Portable fundus camera image:
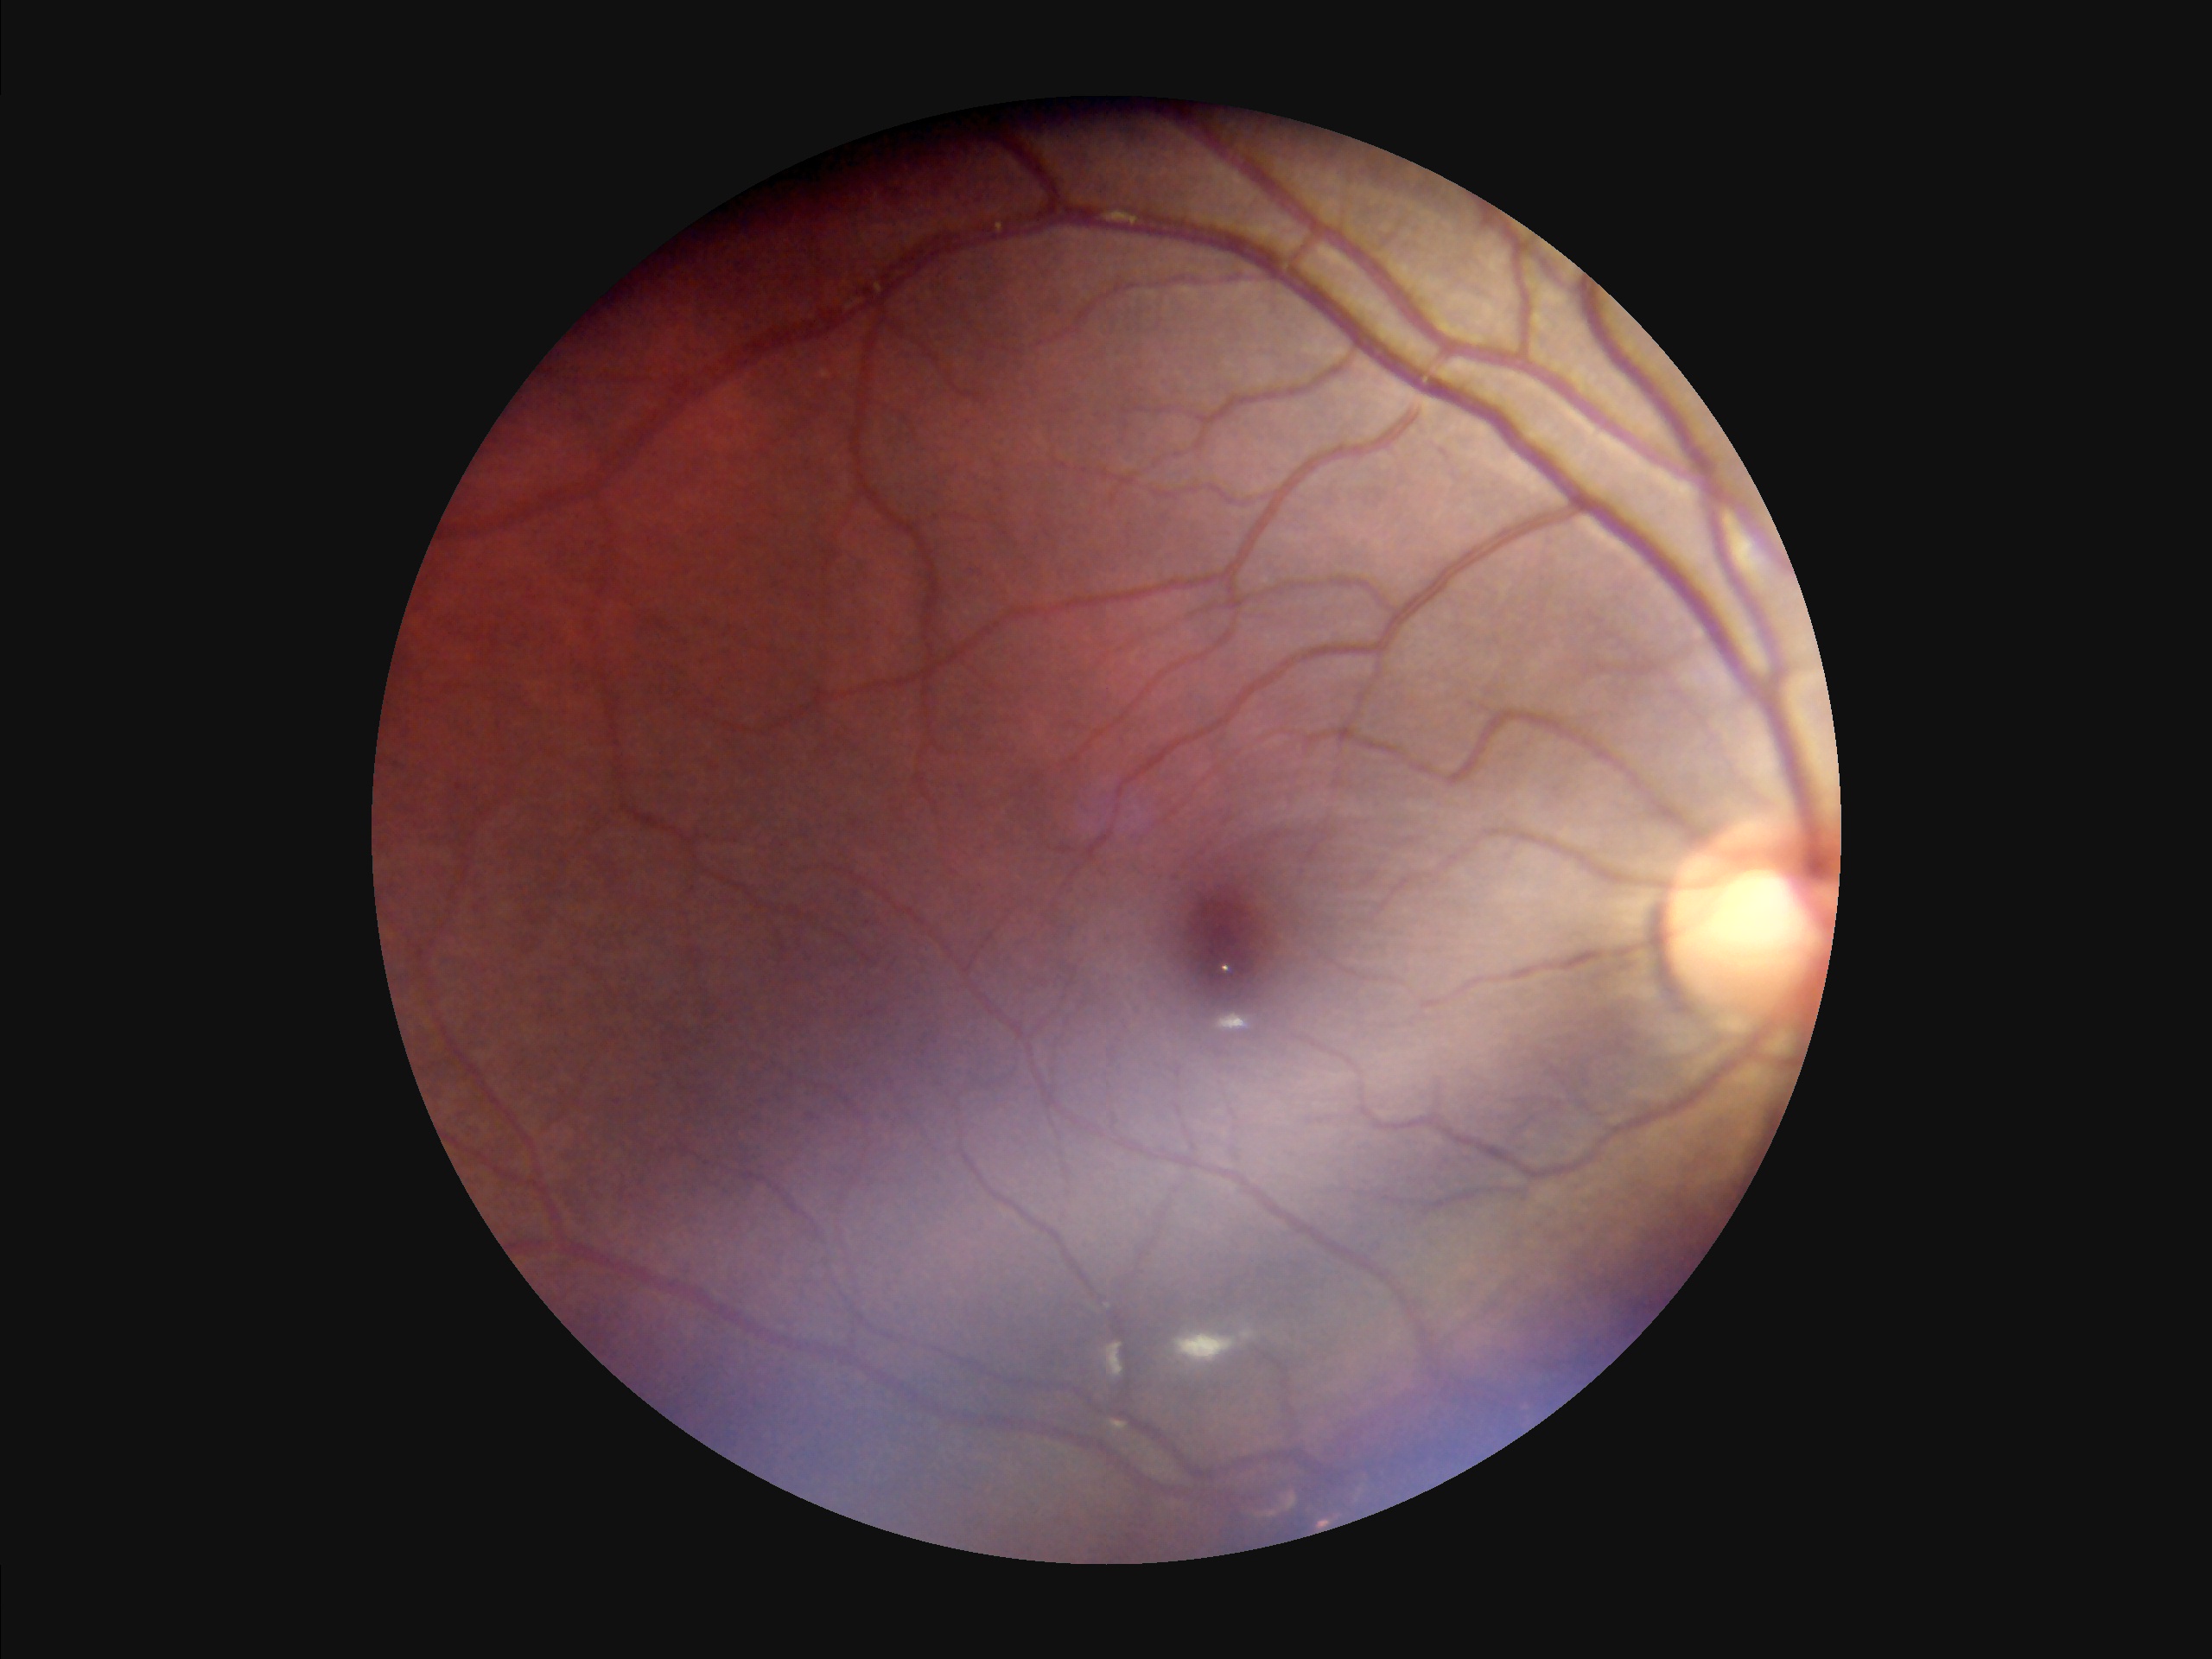
Overall: acceptable
Clarity: reduced
Illumination: poor